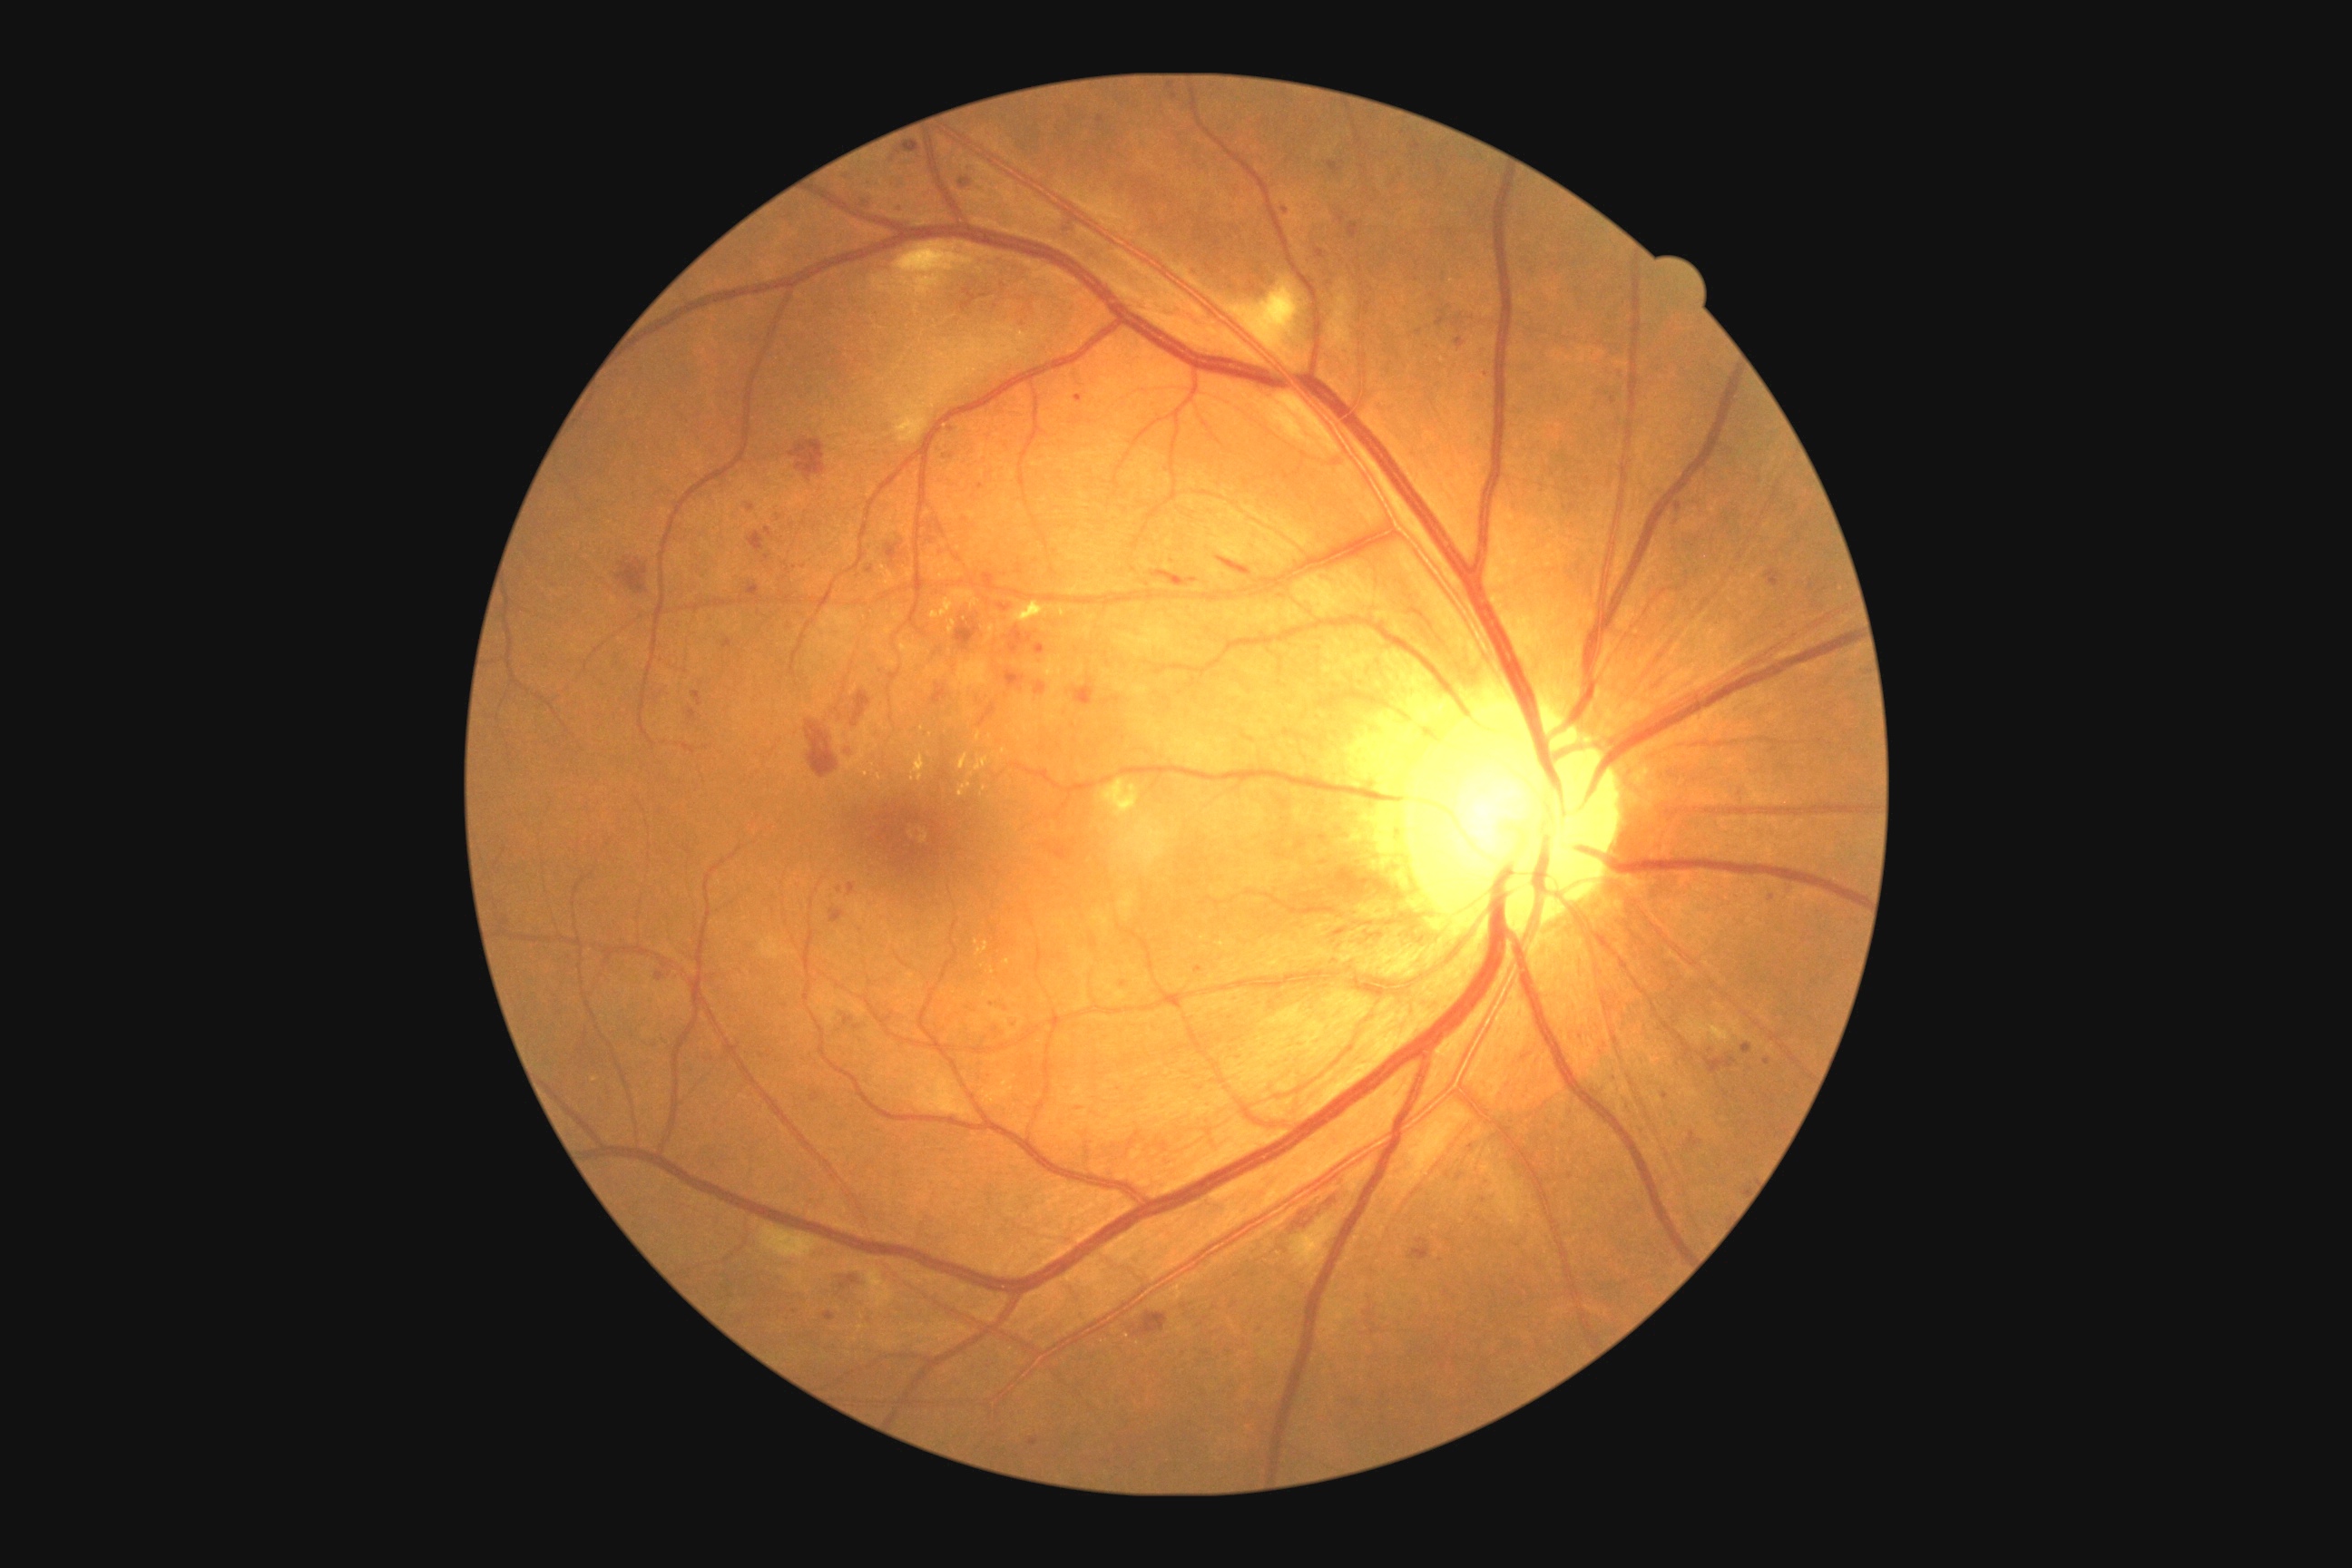
{"dr_grade": "grade 2 (moderate NPDR)"}